Color fundus photograph.
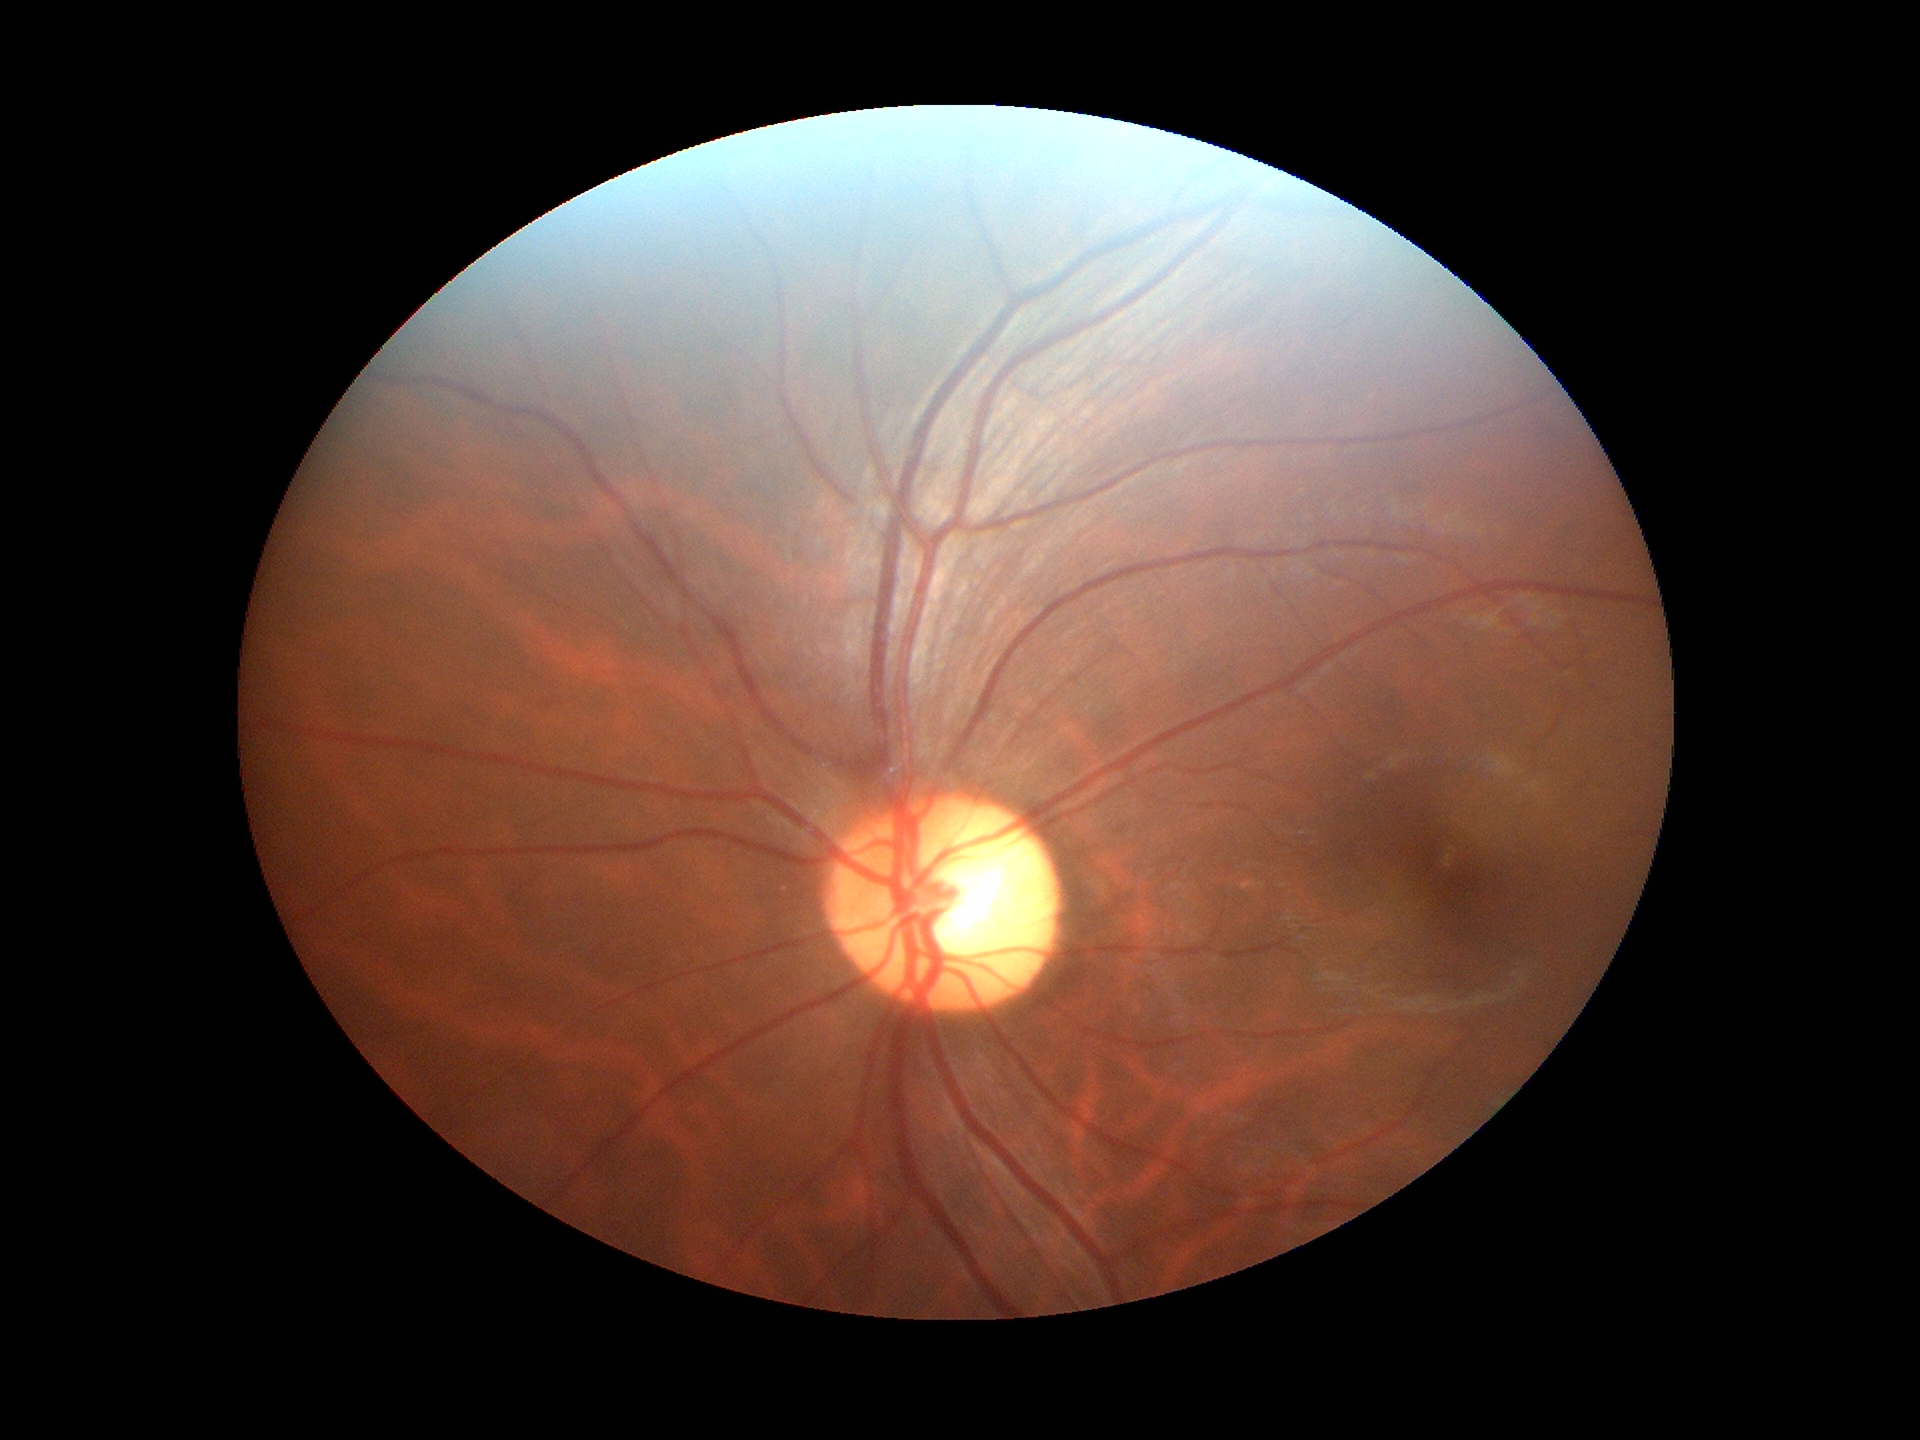
Glaucoma screening: not suspect.
Vertical C/D ratio is 0.55.